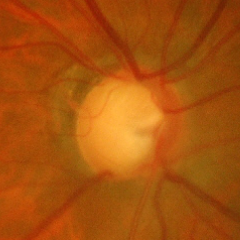 Glaucoma status: severe glaucomatous damage.